Diabetic retinopathy graded by the modified Davis classification: 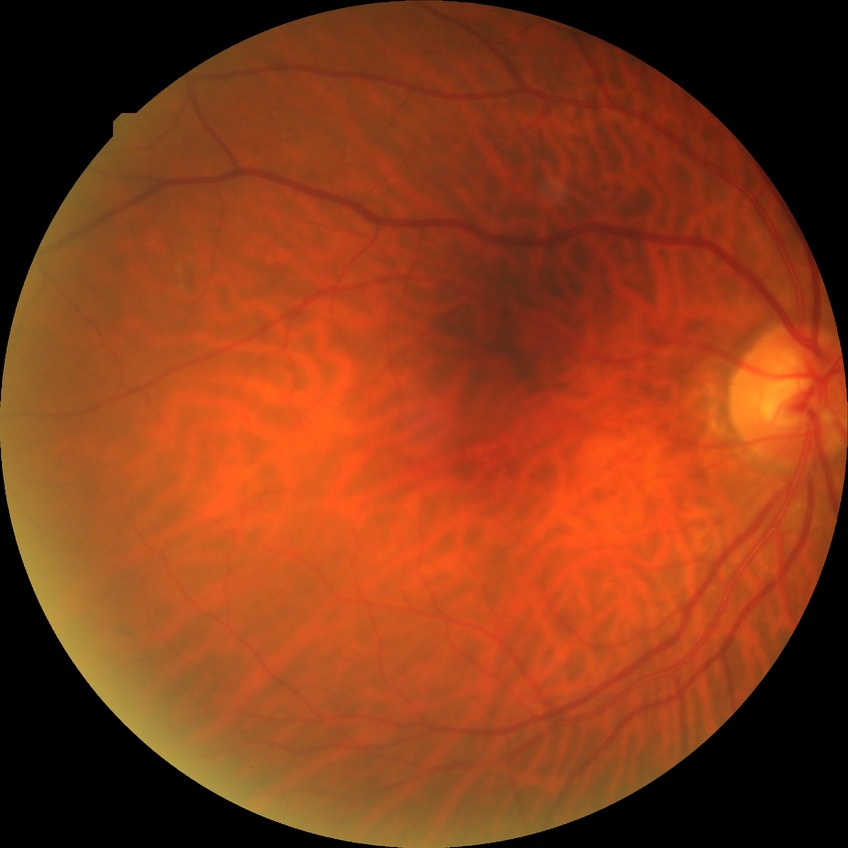

Diabetic retinopathy (DR) is NDR (no diabetic retinopathy).